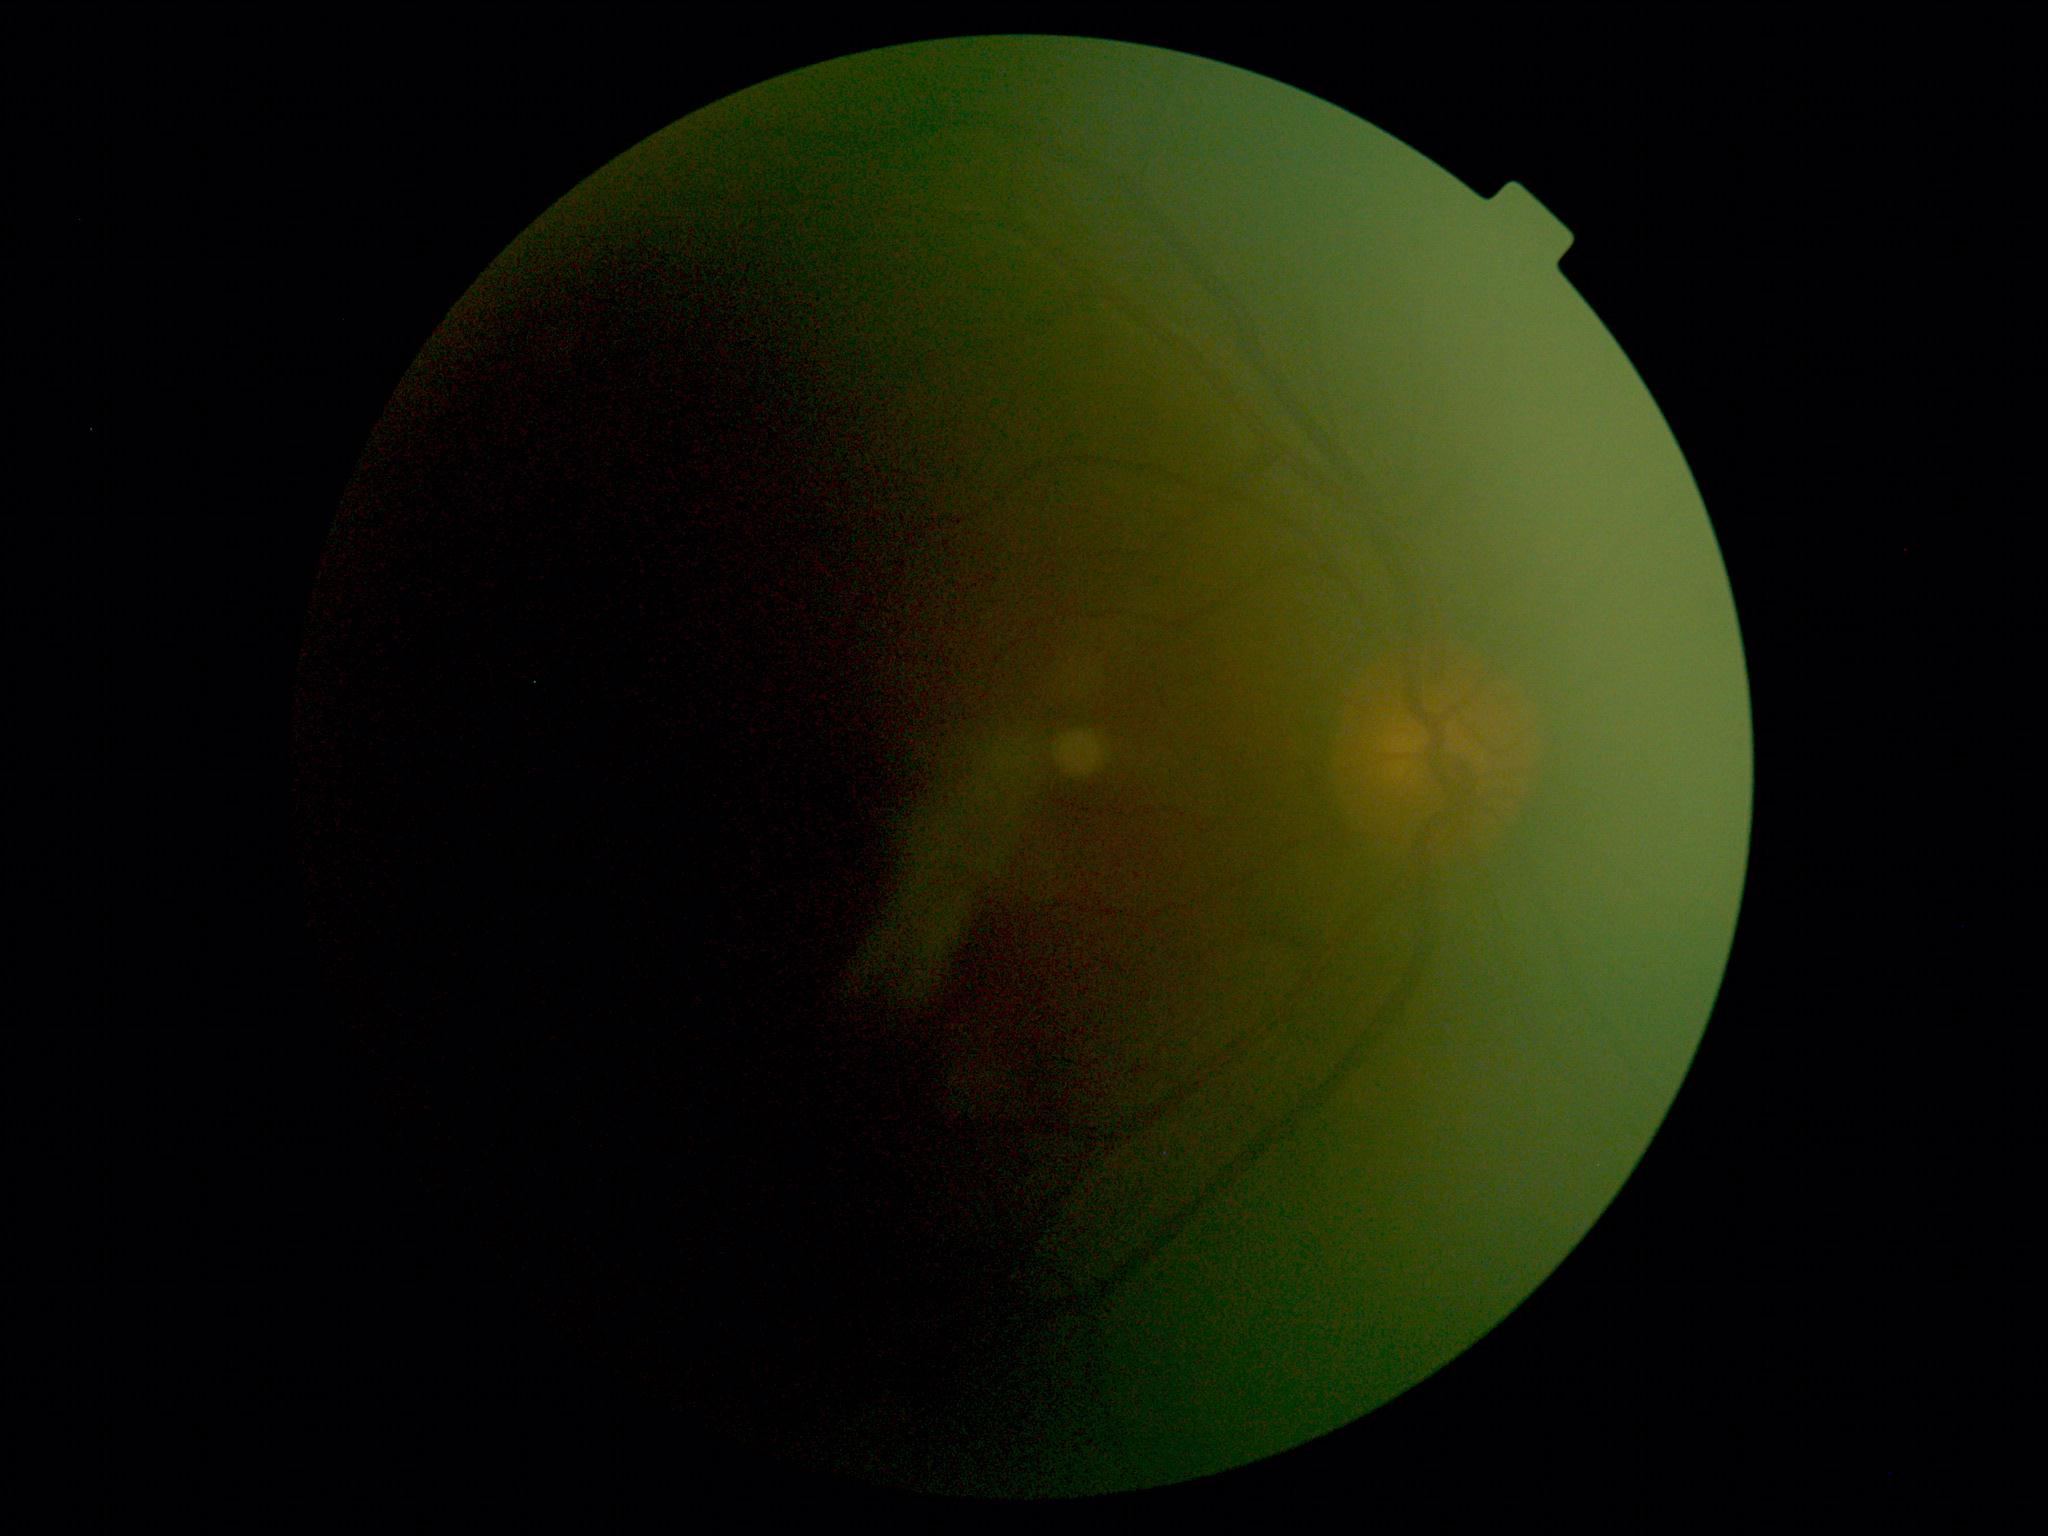 DR grade is ungradable.
Ungradable image — DR severity cannot be determined.